Optic disc-centered crop from a color fundus photograph:
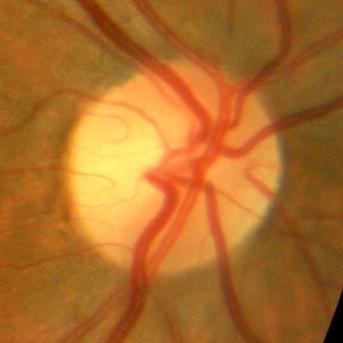
Q: Is glaucoma present?
A: No — no glaucomatous findings.